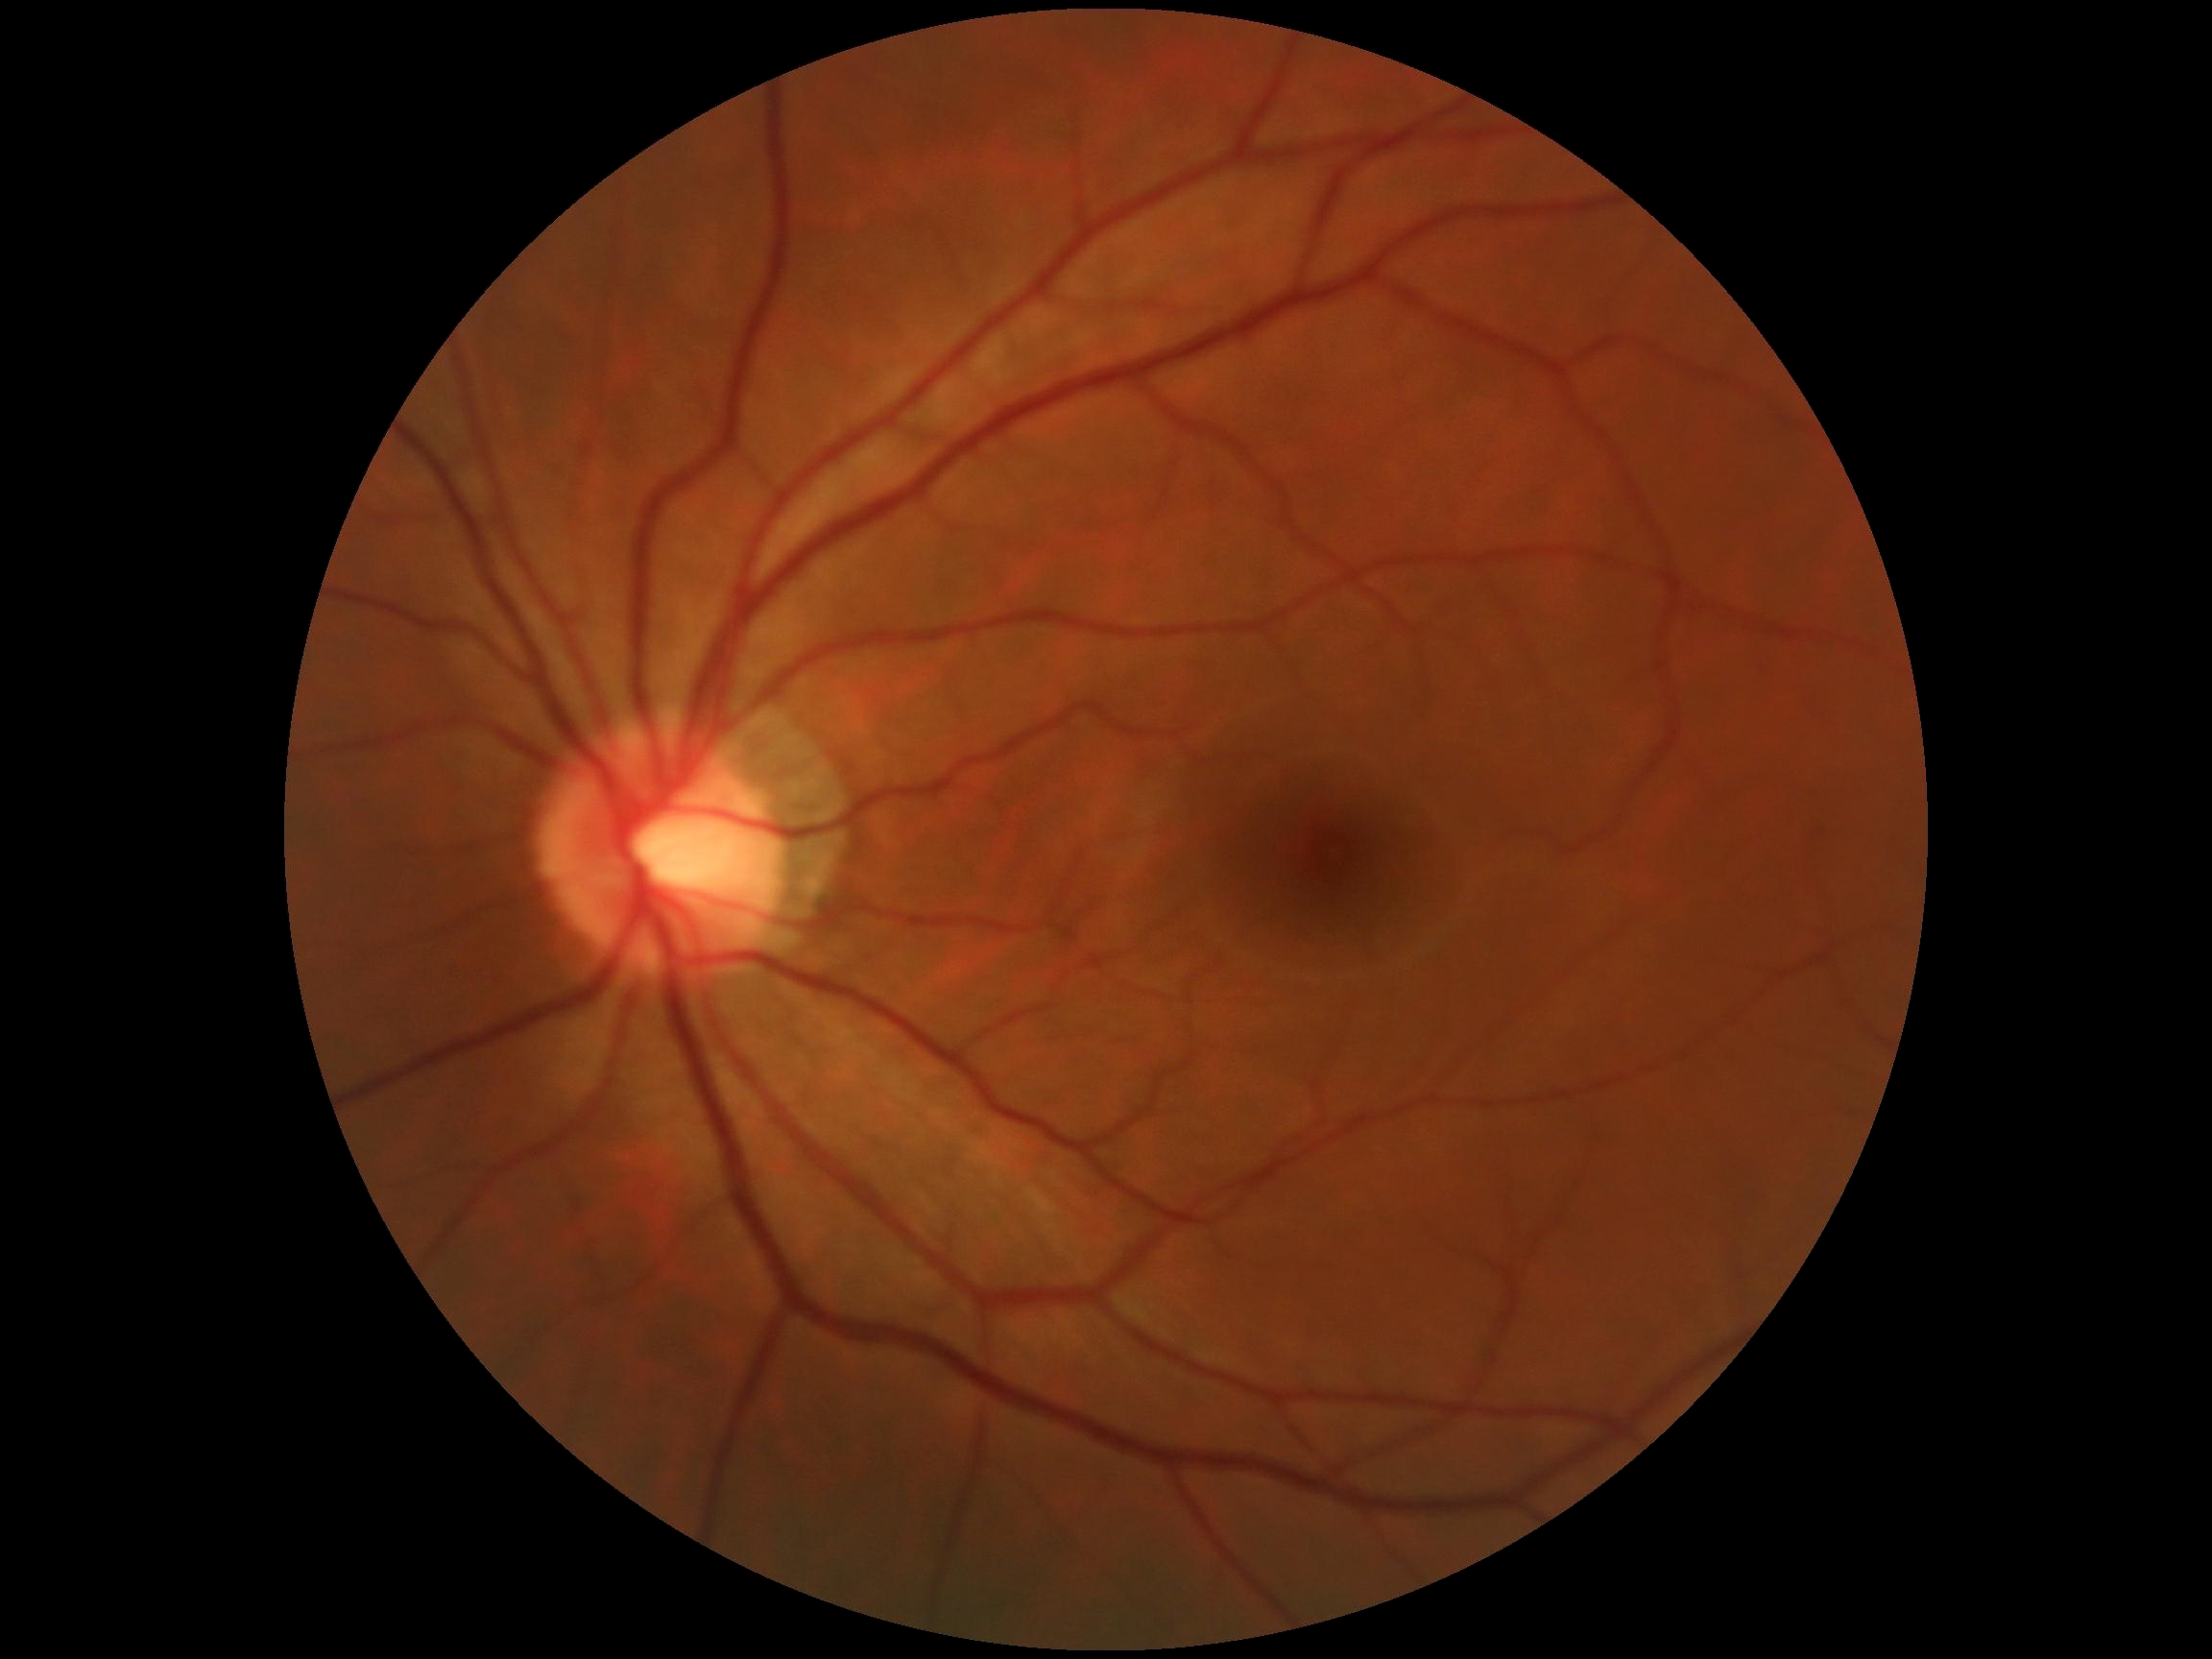

– DR grade: 0/4